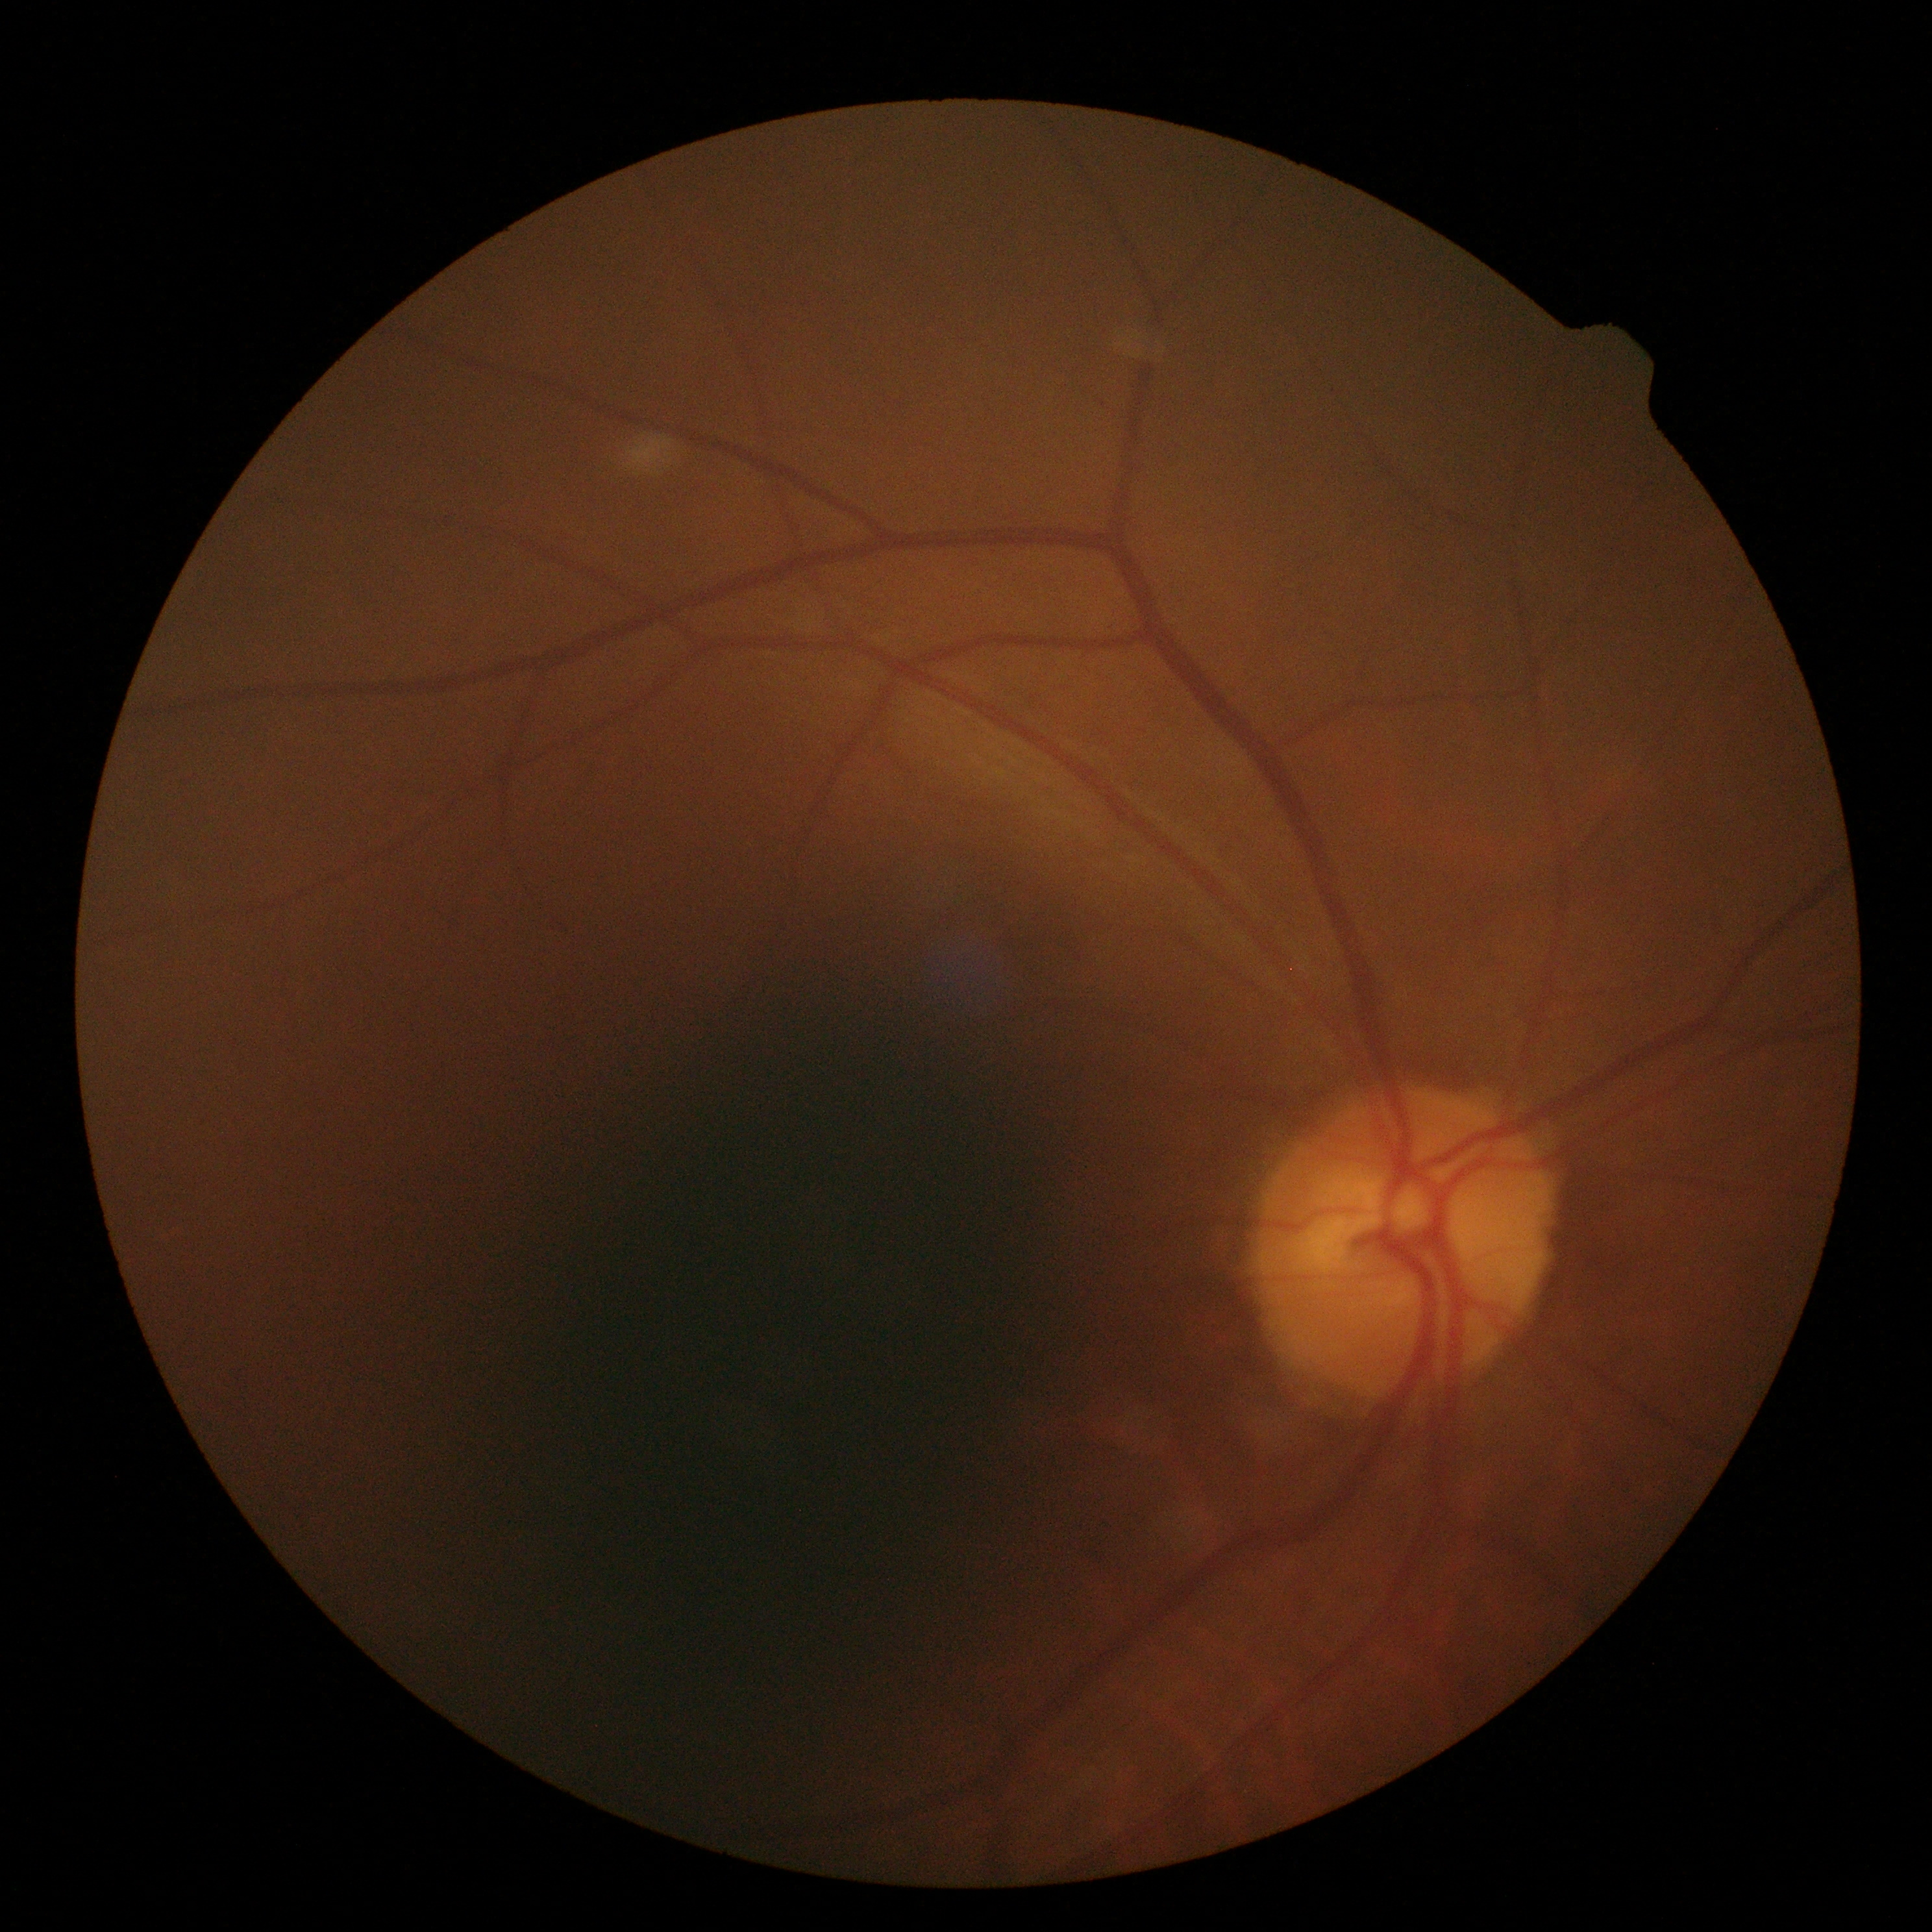

diabetic retinopathy grade=0 (no apparent retinopathy).